Image size 2352x1568, CFP — 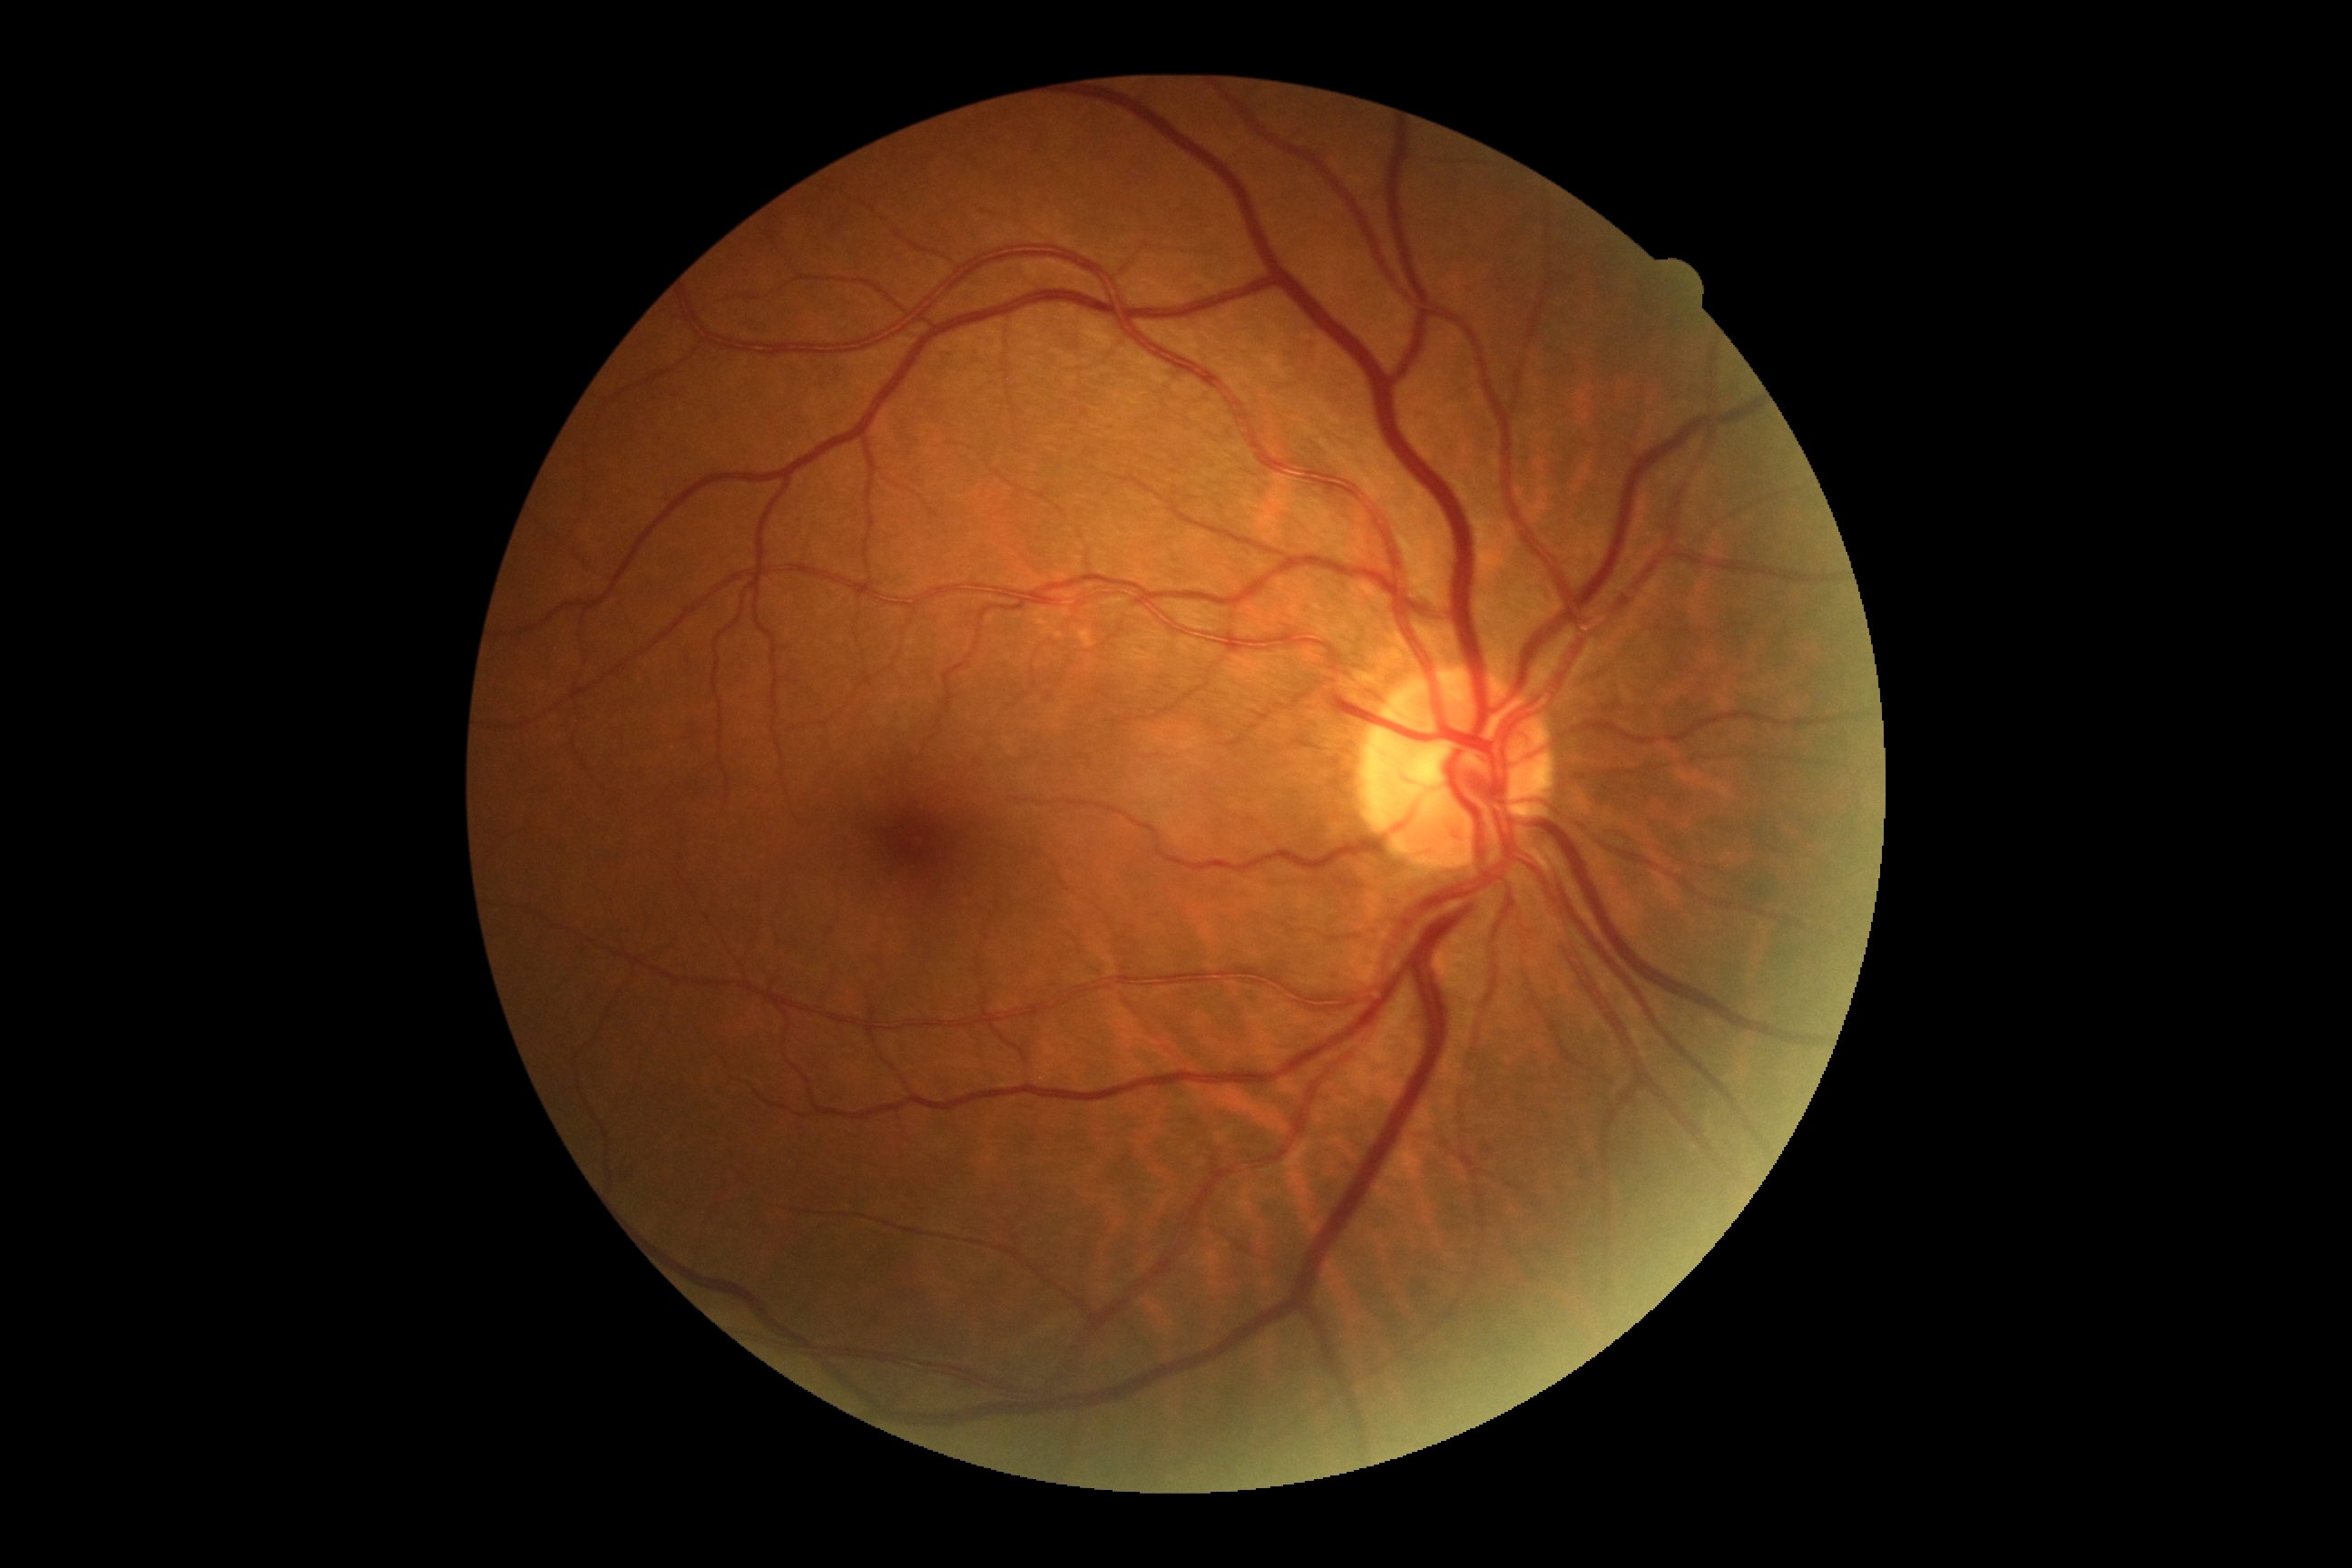
diabetic retinopathy grade: 0 (no apparent retinopathy) — no visible signs of diabetic retinopathy
DR impression: no DR findings